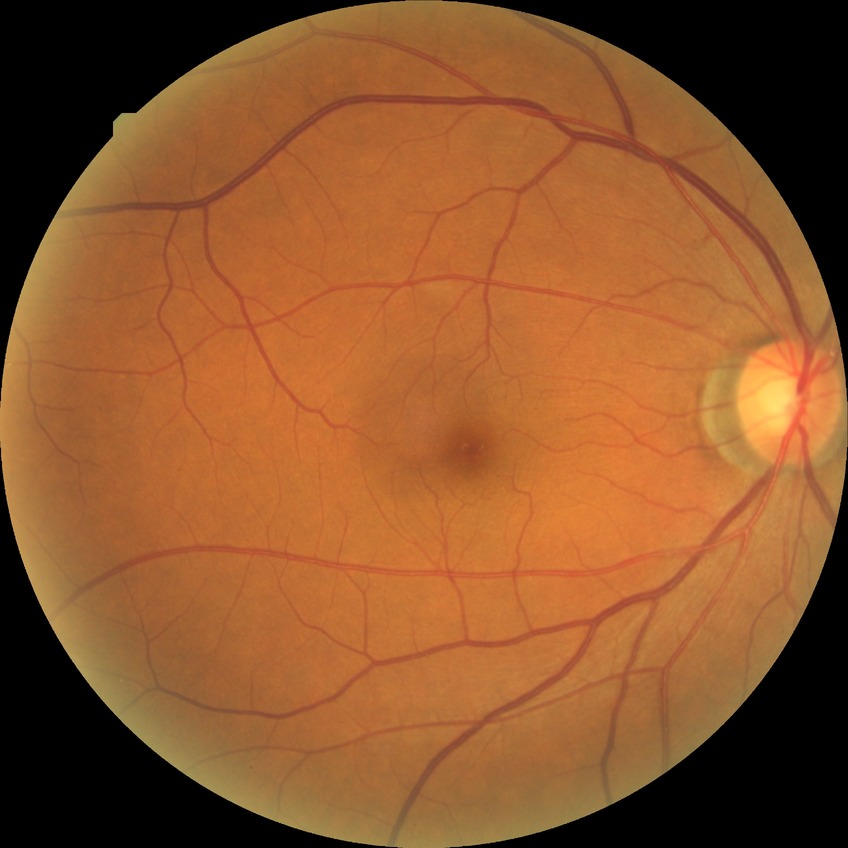

DR stage is NDR.